640 by 480 pixels; infant wide-field fundus photograph; acquired on the Clarity RetCam 3
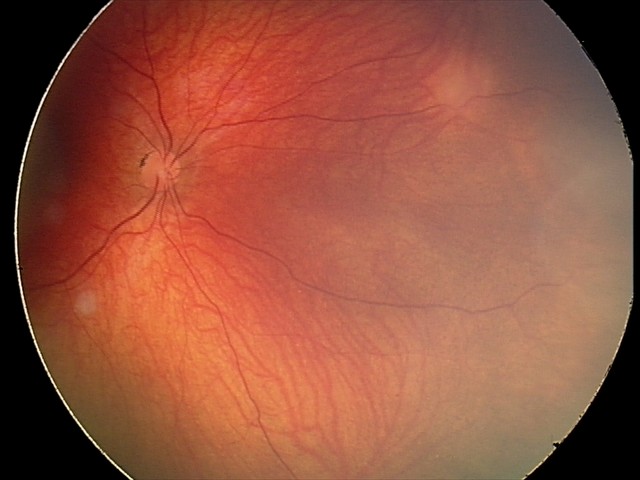
Diagnosis from this screening exam: retinal astrocytic hamartoma.